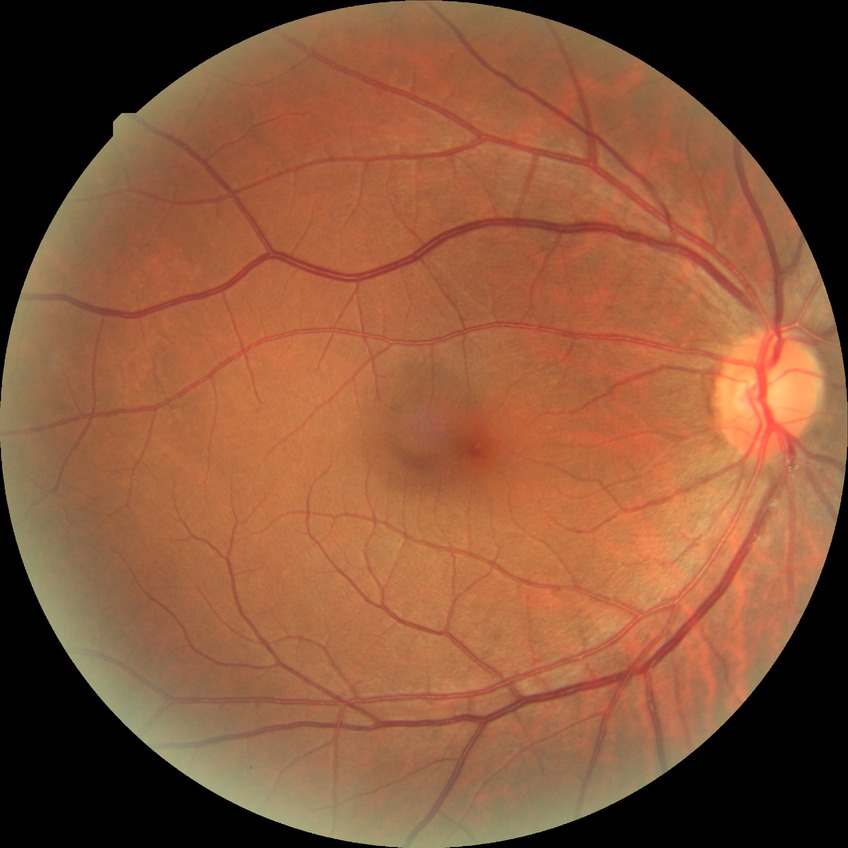
- diabetic retinopathy (DR) — NDR (no diabetic retinopathy)